512 x 512 pixels; color fundus image
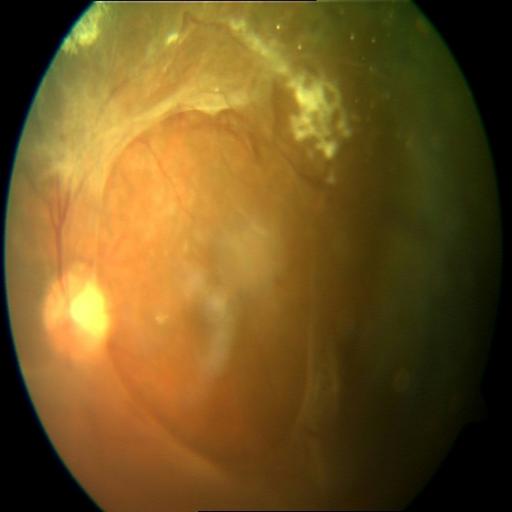
Impression: retinal traction (RT).